Davis DR grading — 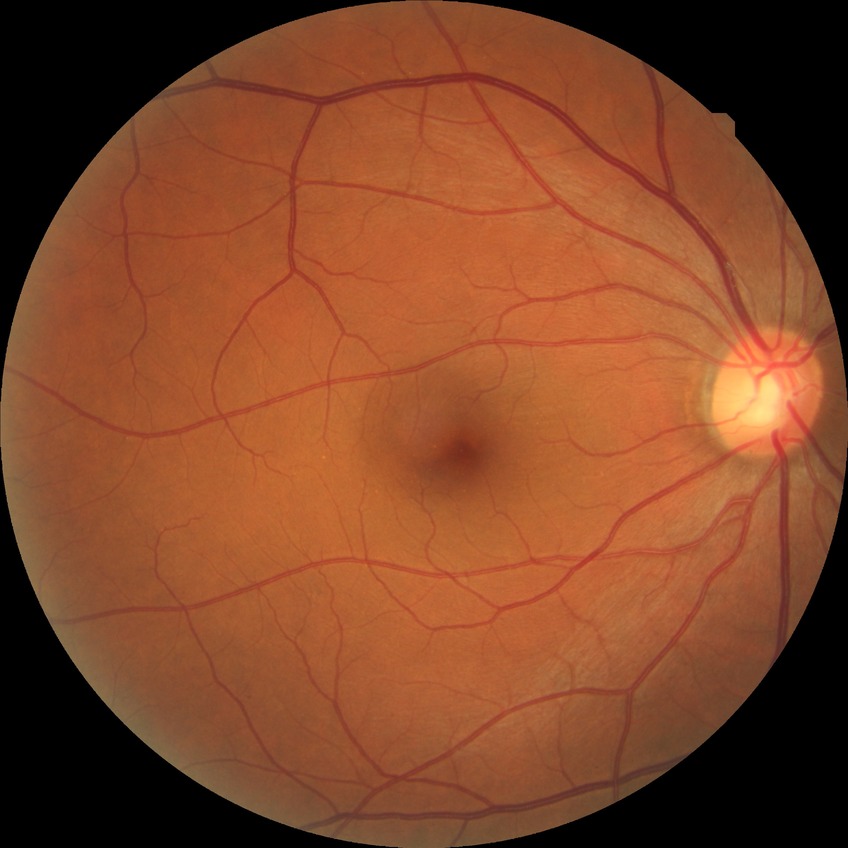

{"davis_grade": "no diabetic retinopathy (NDR)"}